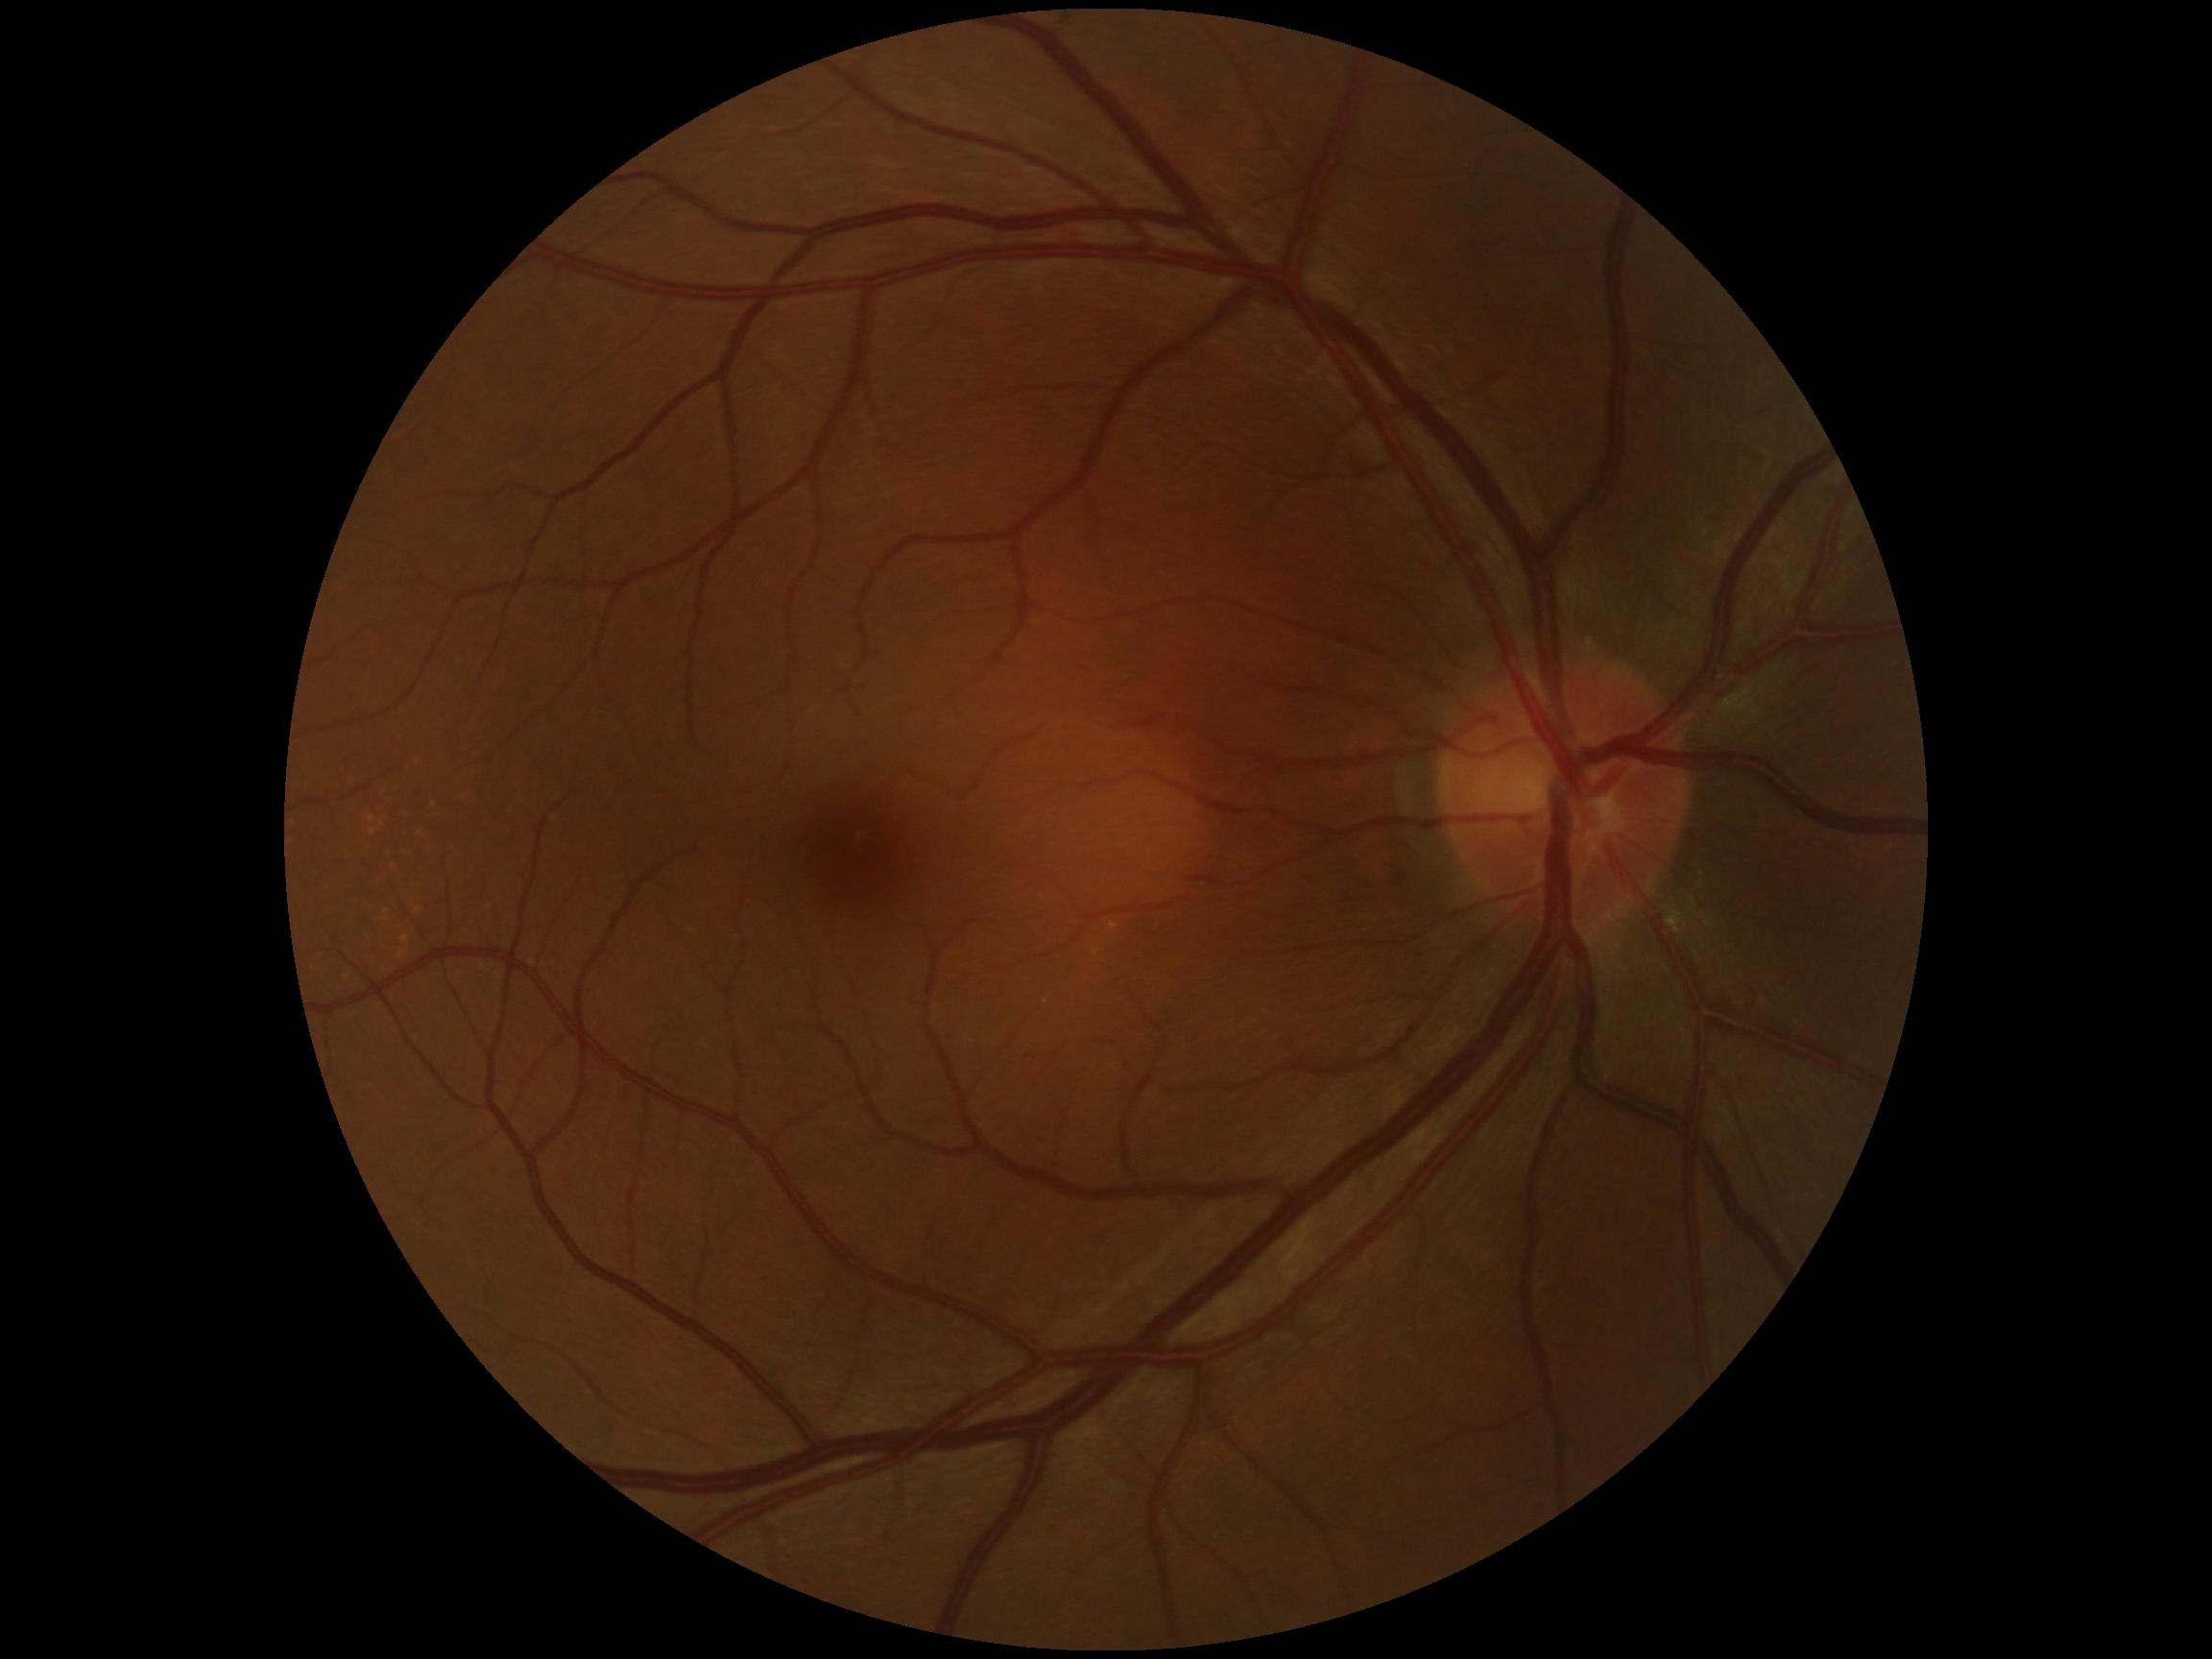
diabetic retinopathy (DR) = 0/4 — no visible signs of diabetic retinopathy.